Fundus photo. 45-degree field of view — 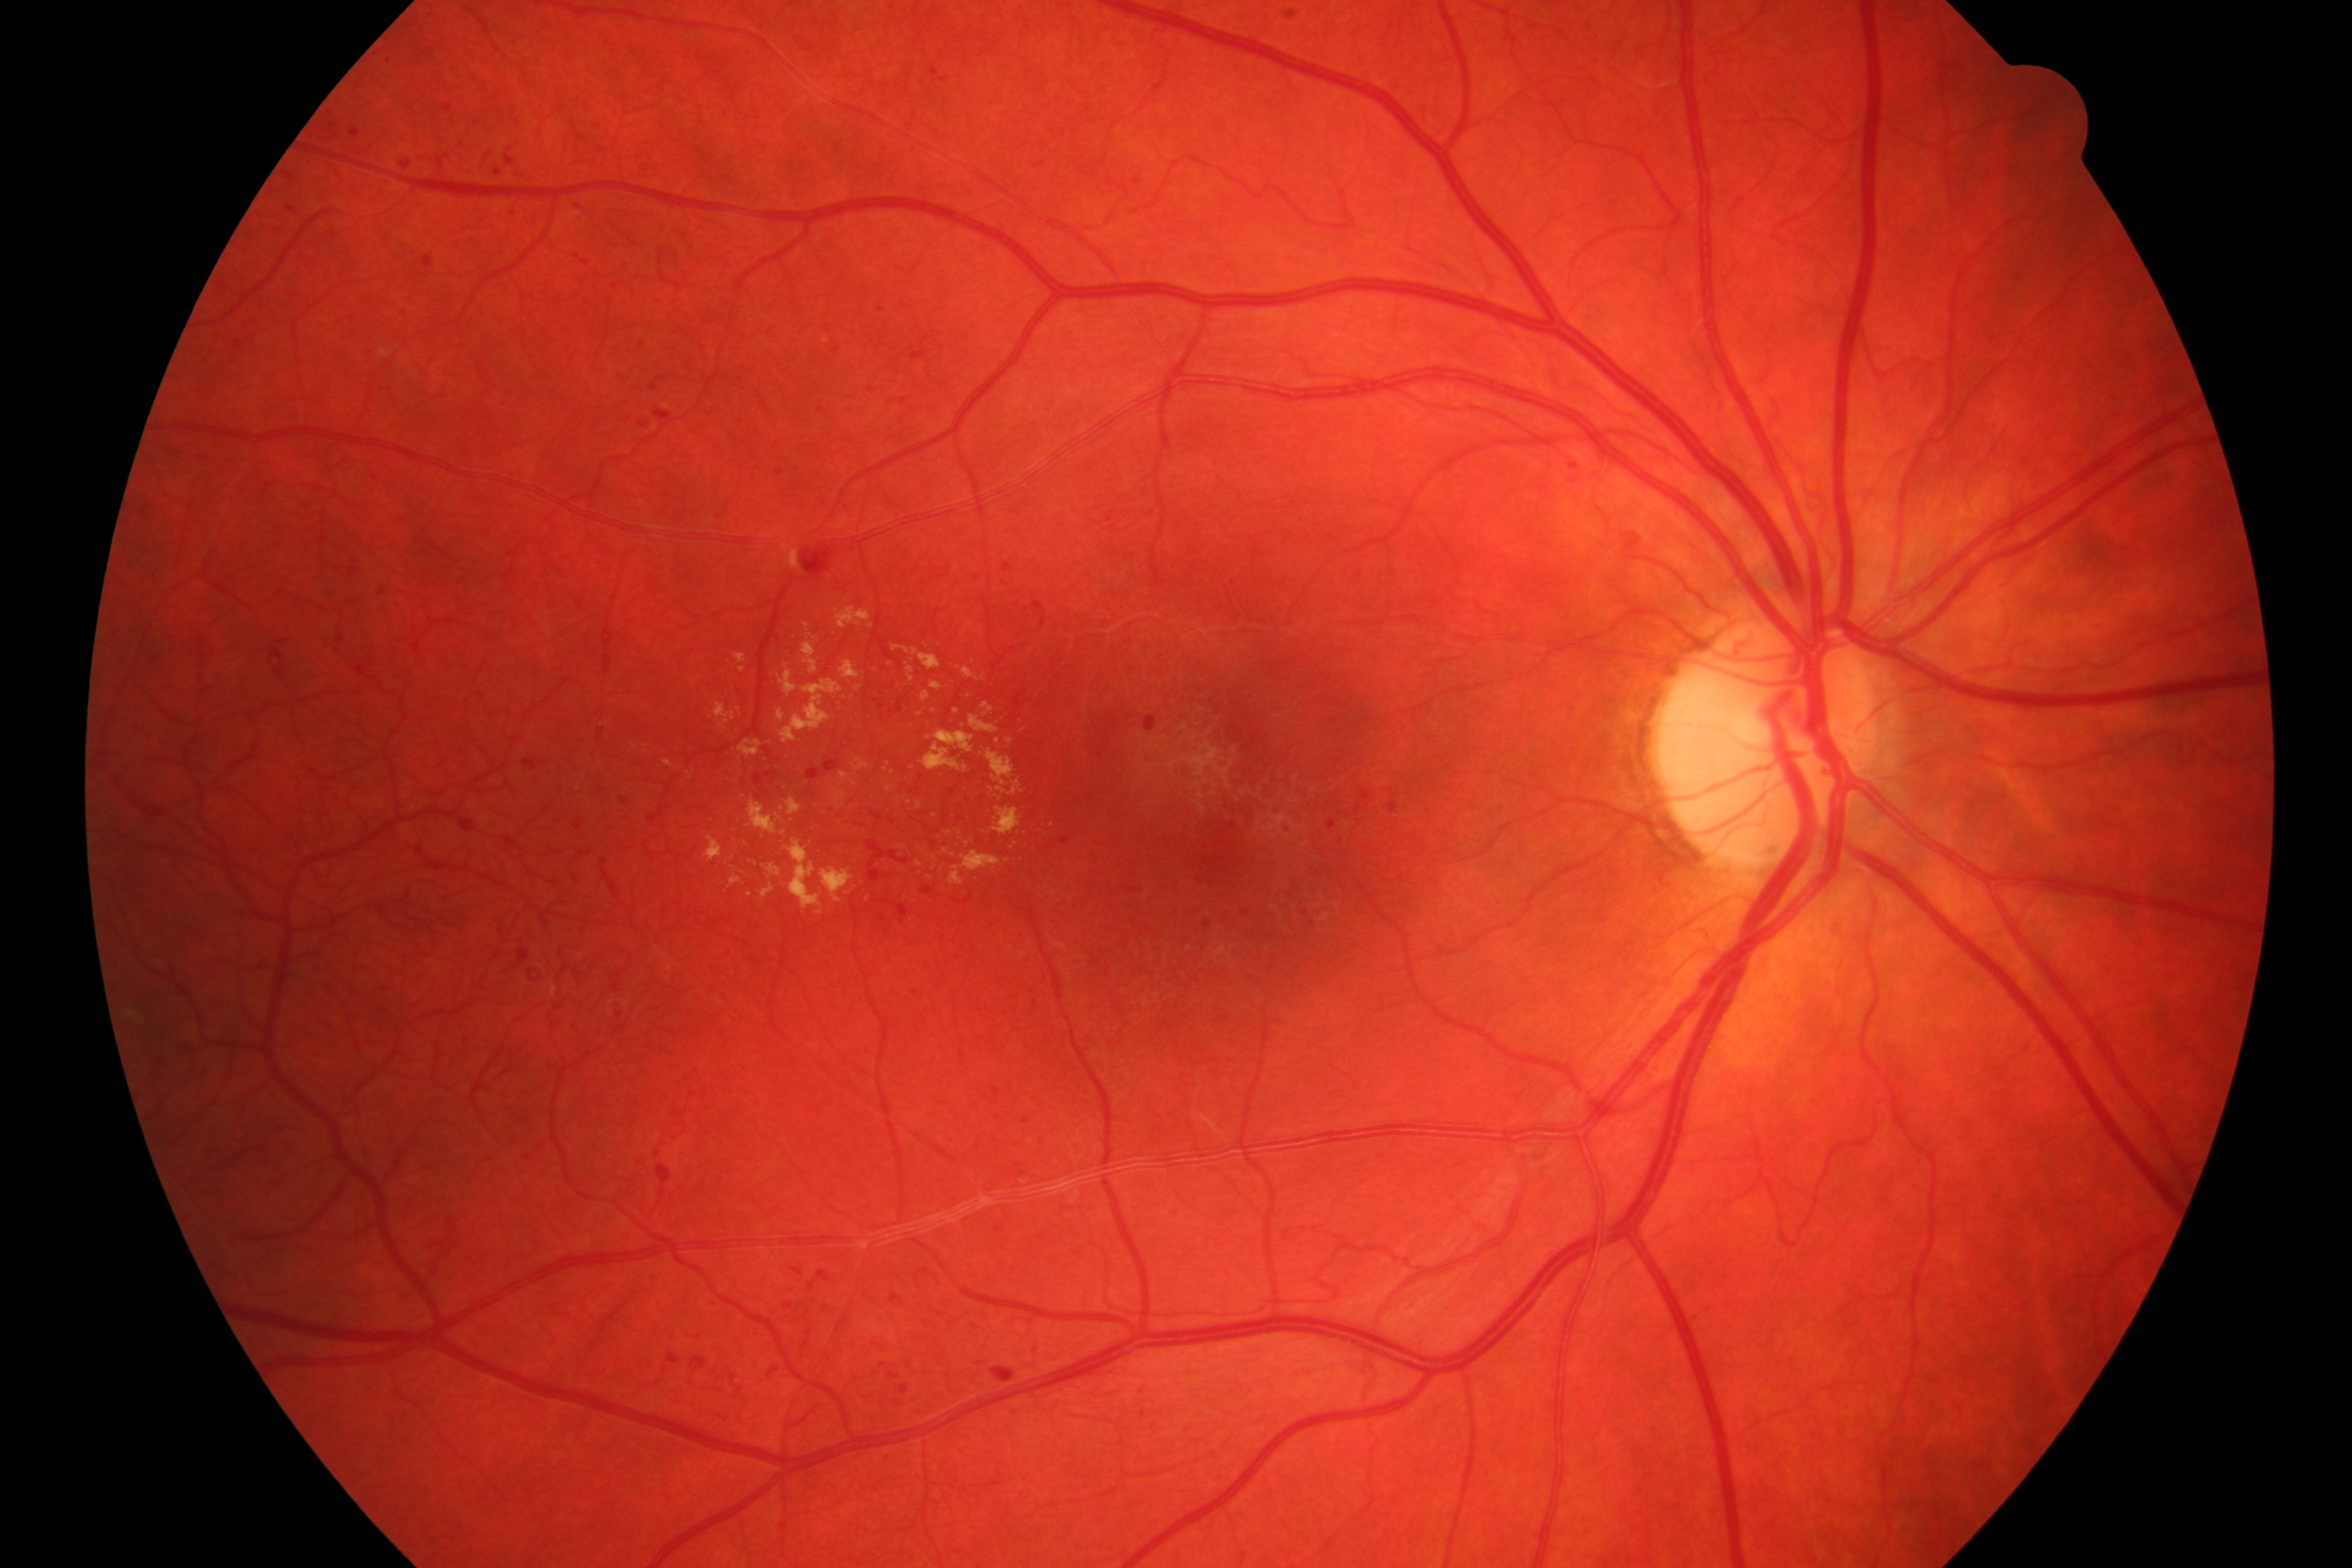

Findings consistent with diabetic retinopathy.